DR severity per modified Davis staging, posterior pole color fundus photograph — 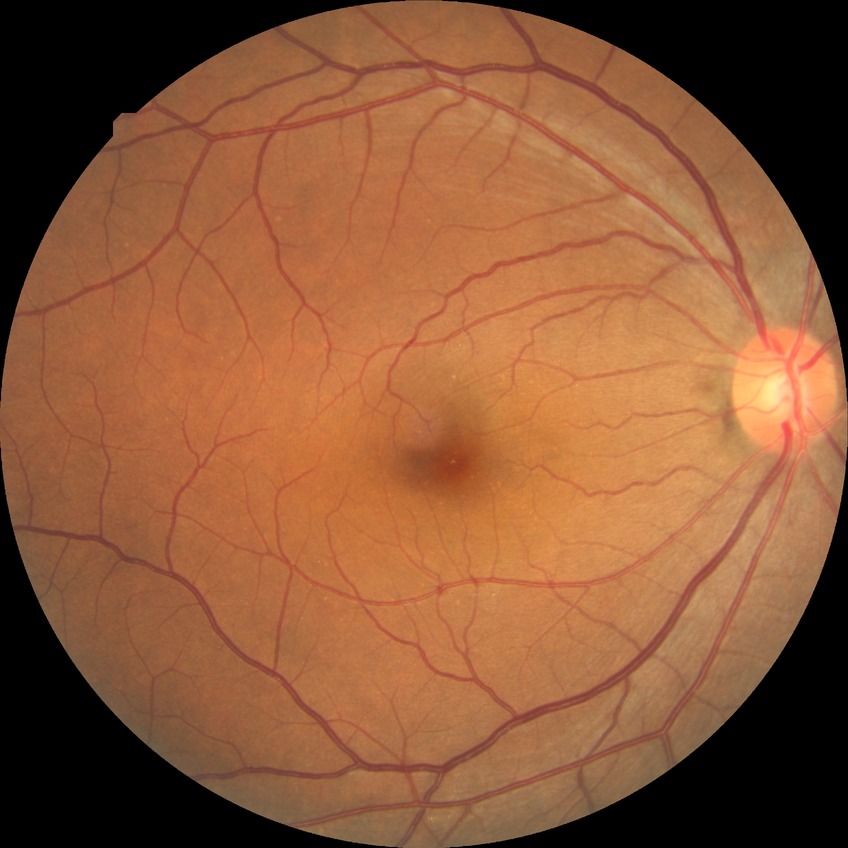
- DR — NDR